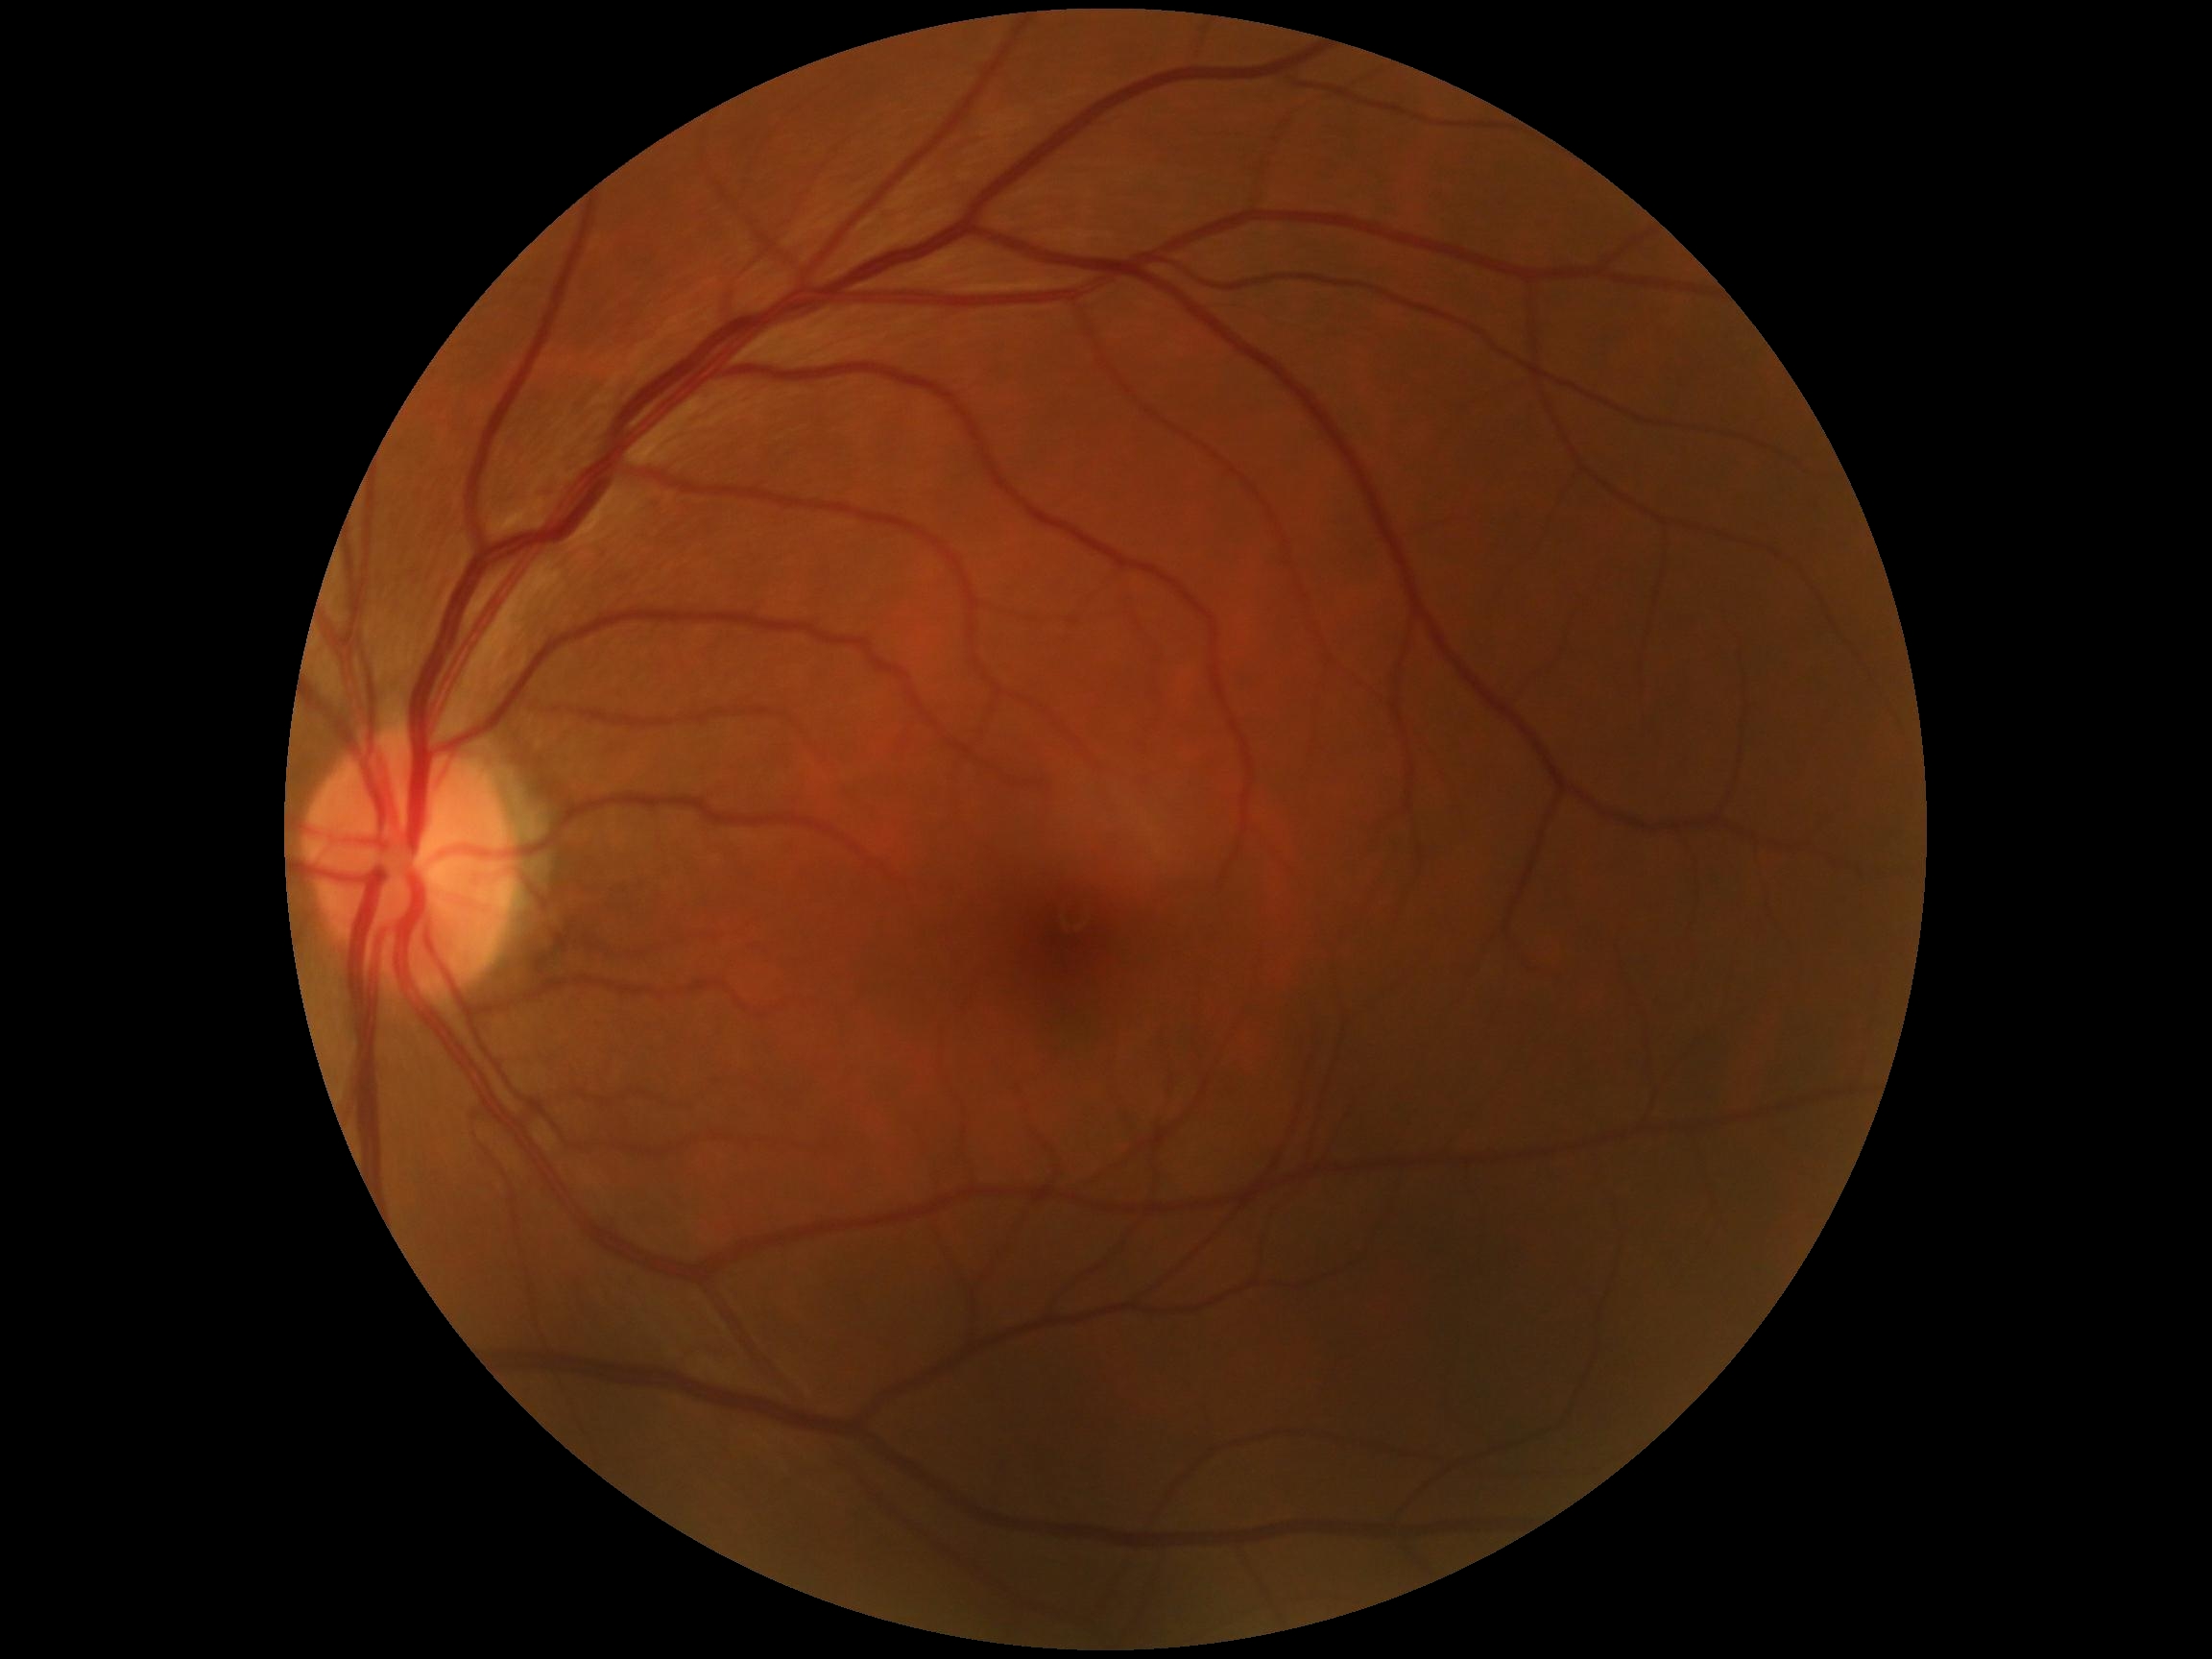

DR impression: no signs of DR; retinopathy: grade 0 (no apparent retinopathy).